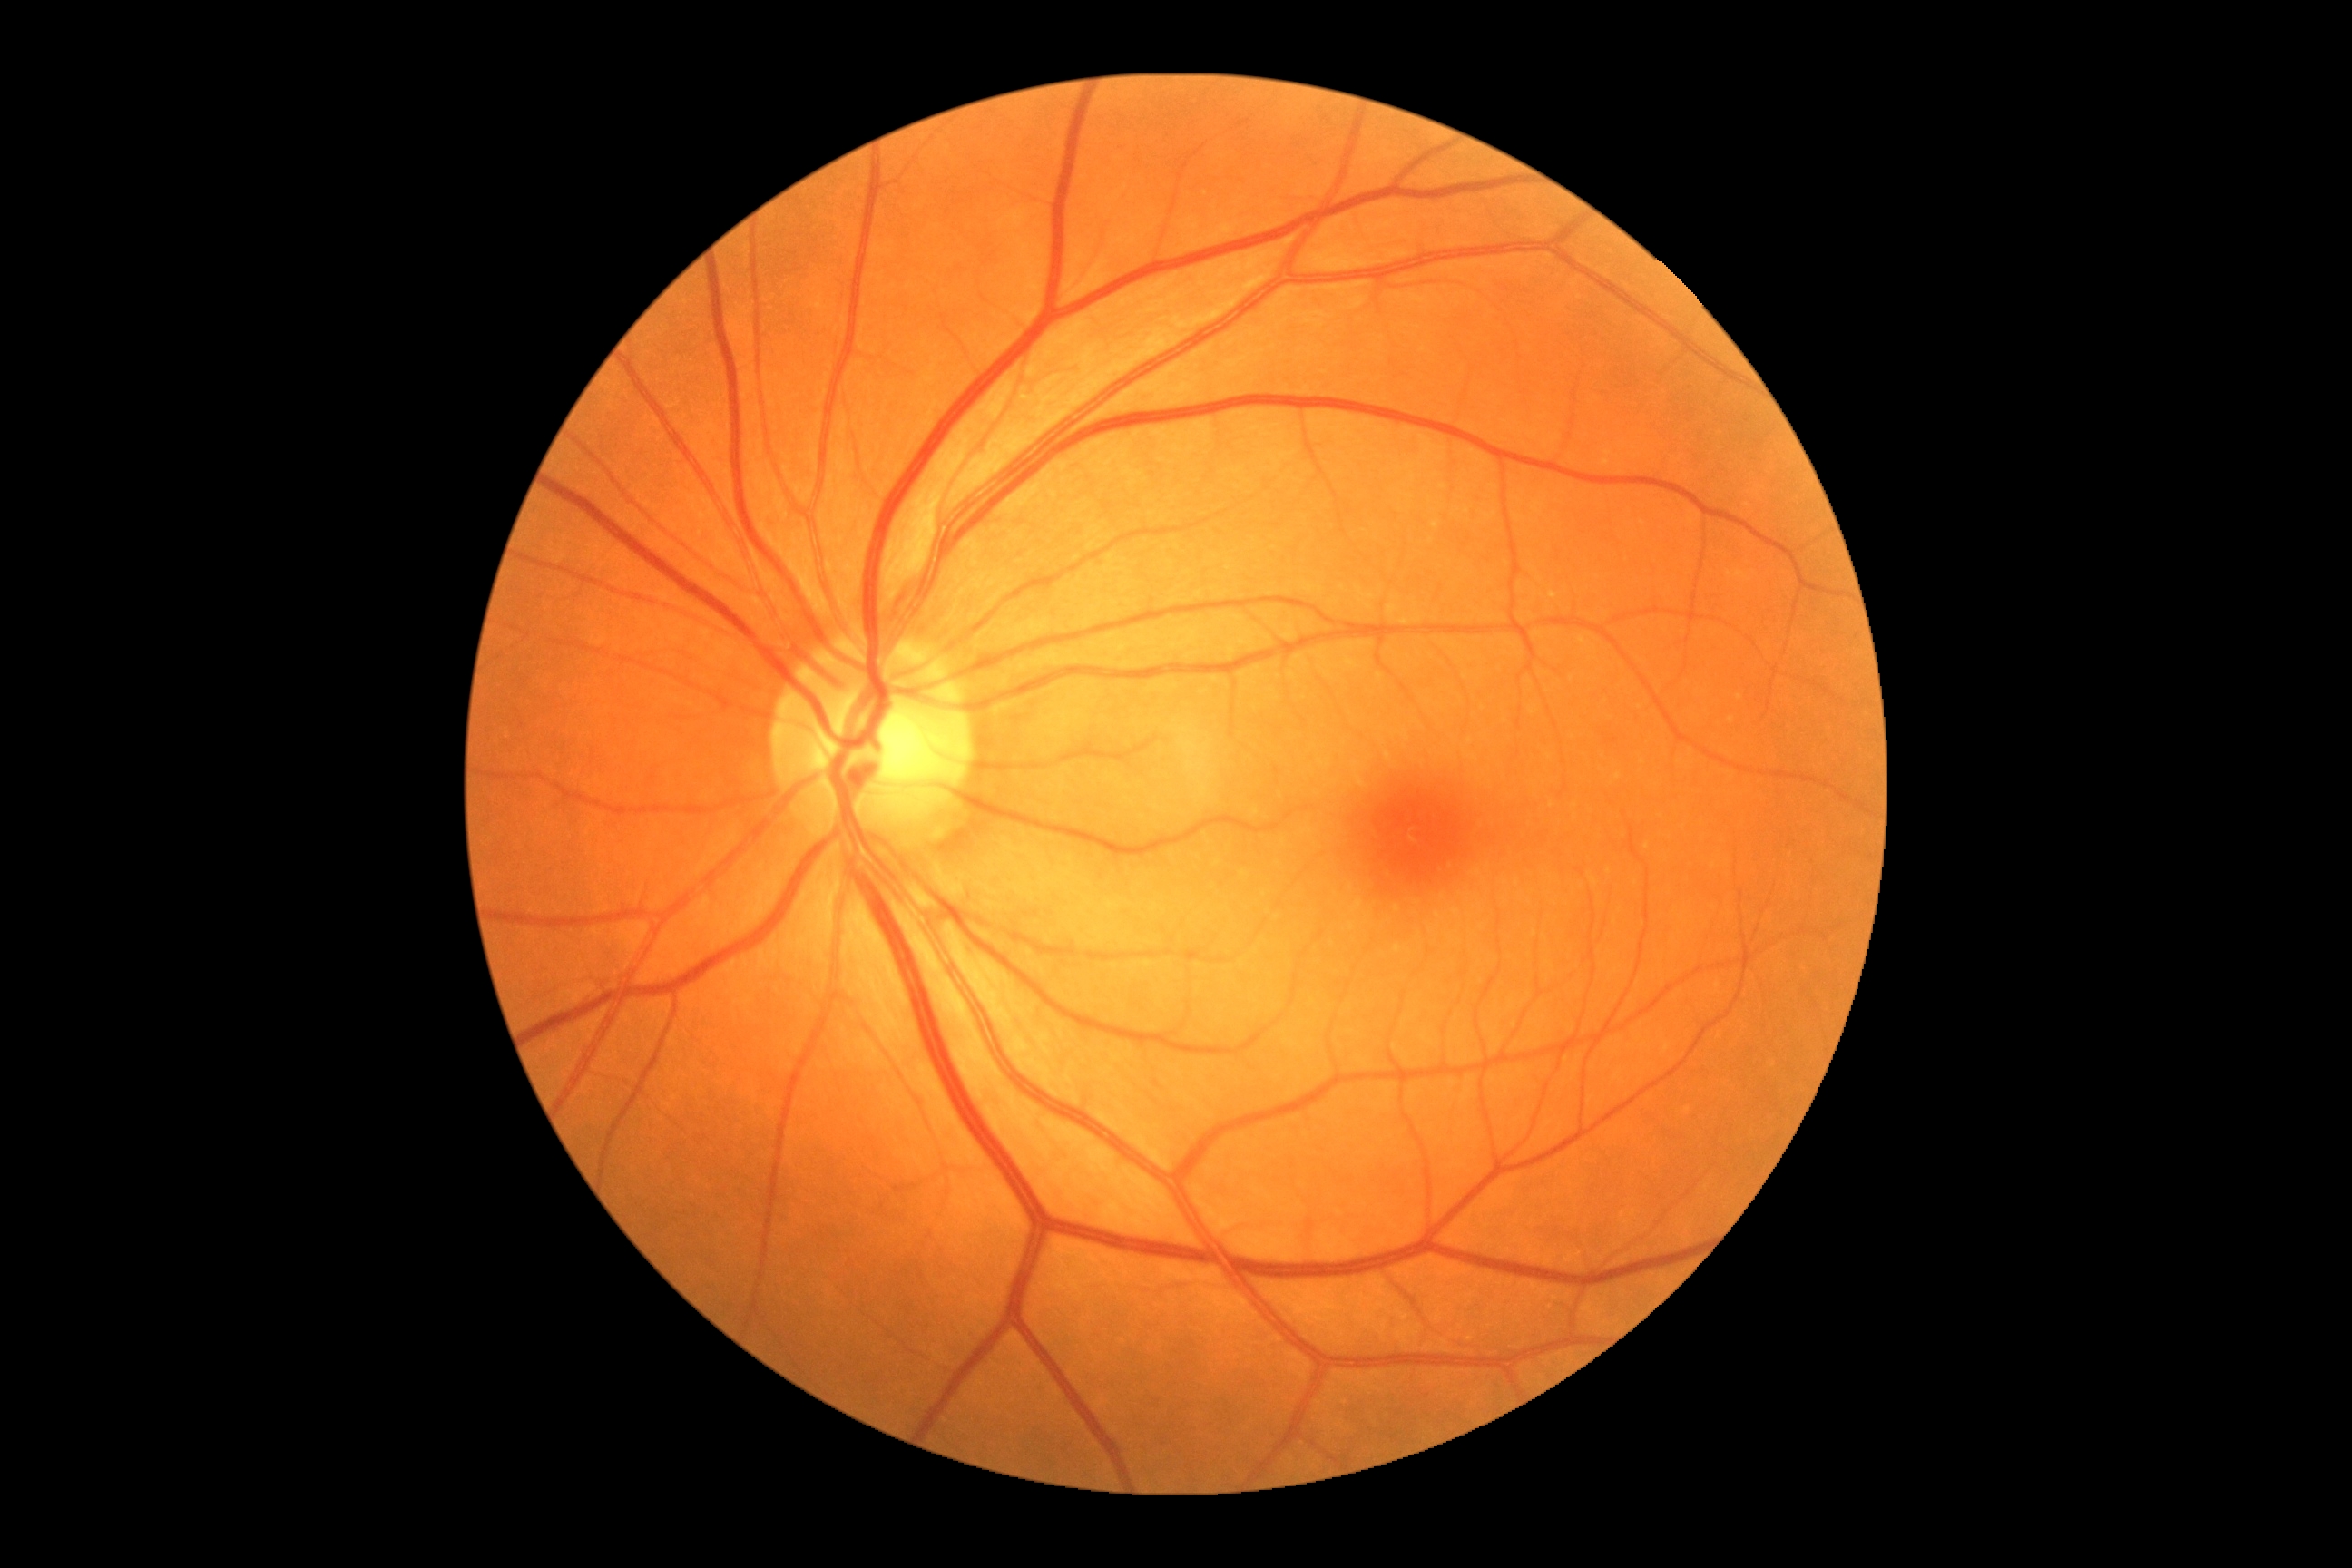

Findings:
* diabetic retinopathy (DR) — grade 0 (no apparent retinopathy)